Retinal fundus photograph; modified Davis grading; 848x848px
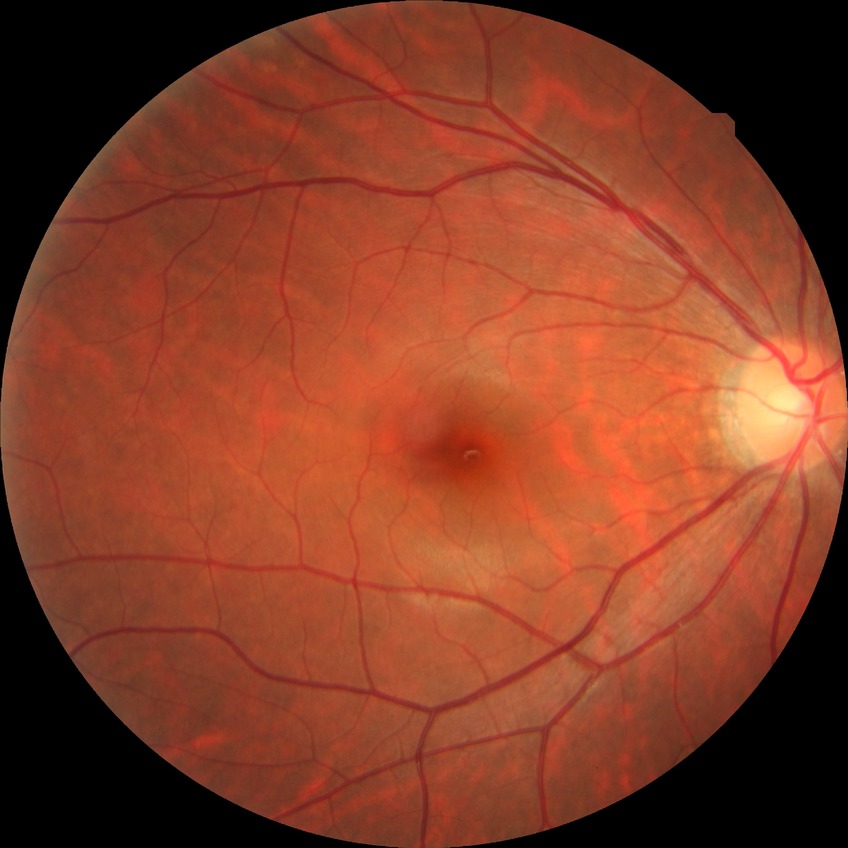
Diabetic retinopathy (DR) is no diabetic retinopathy (NDR).